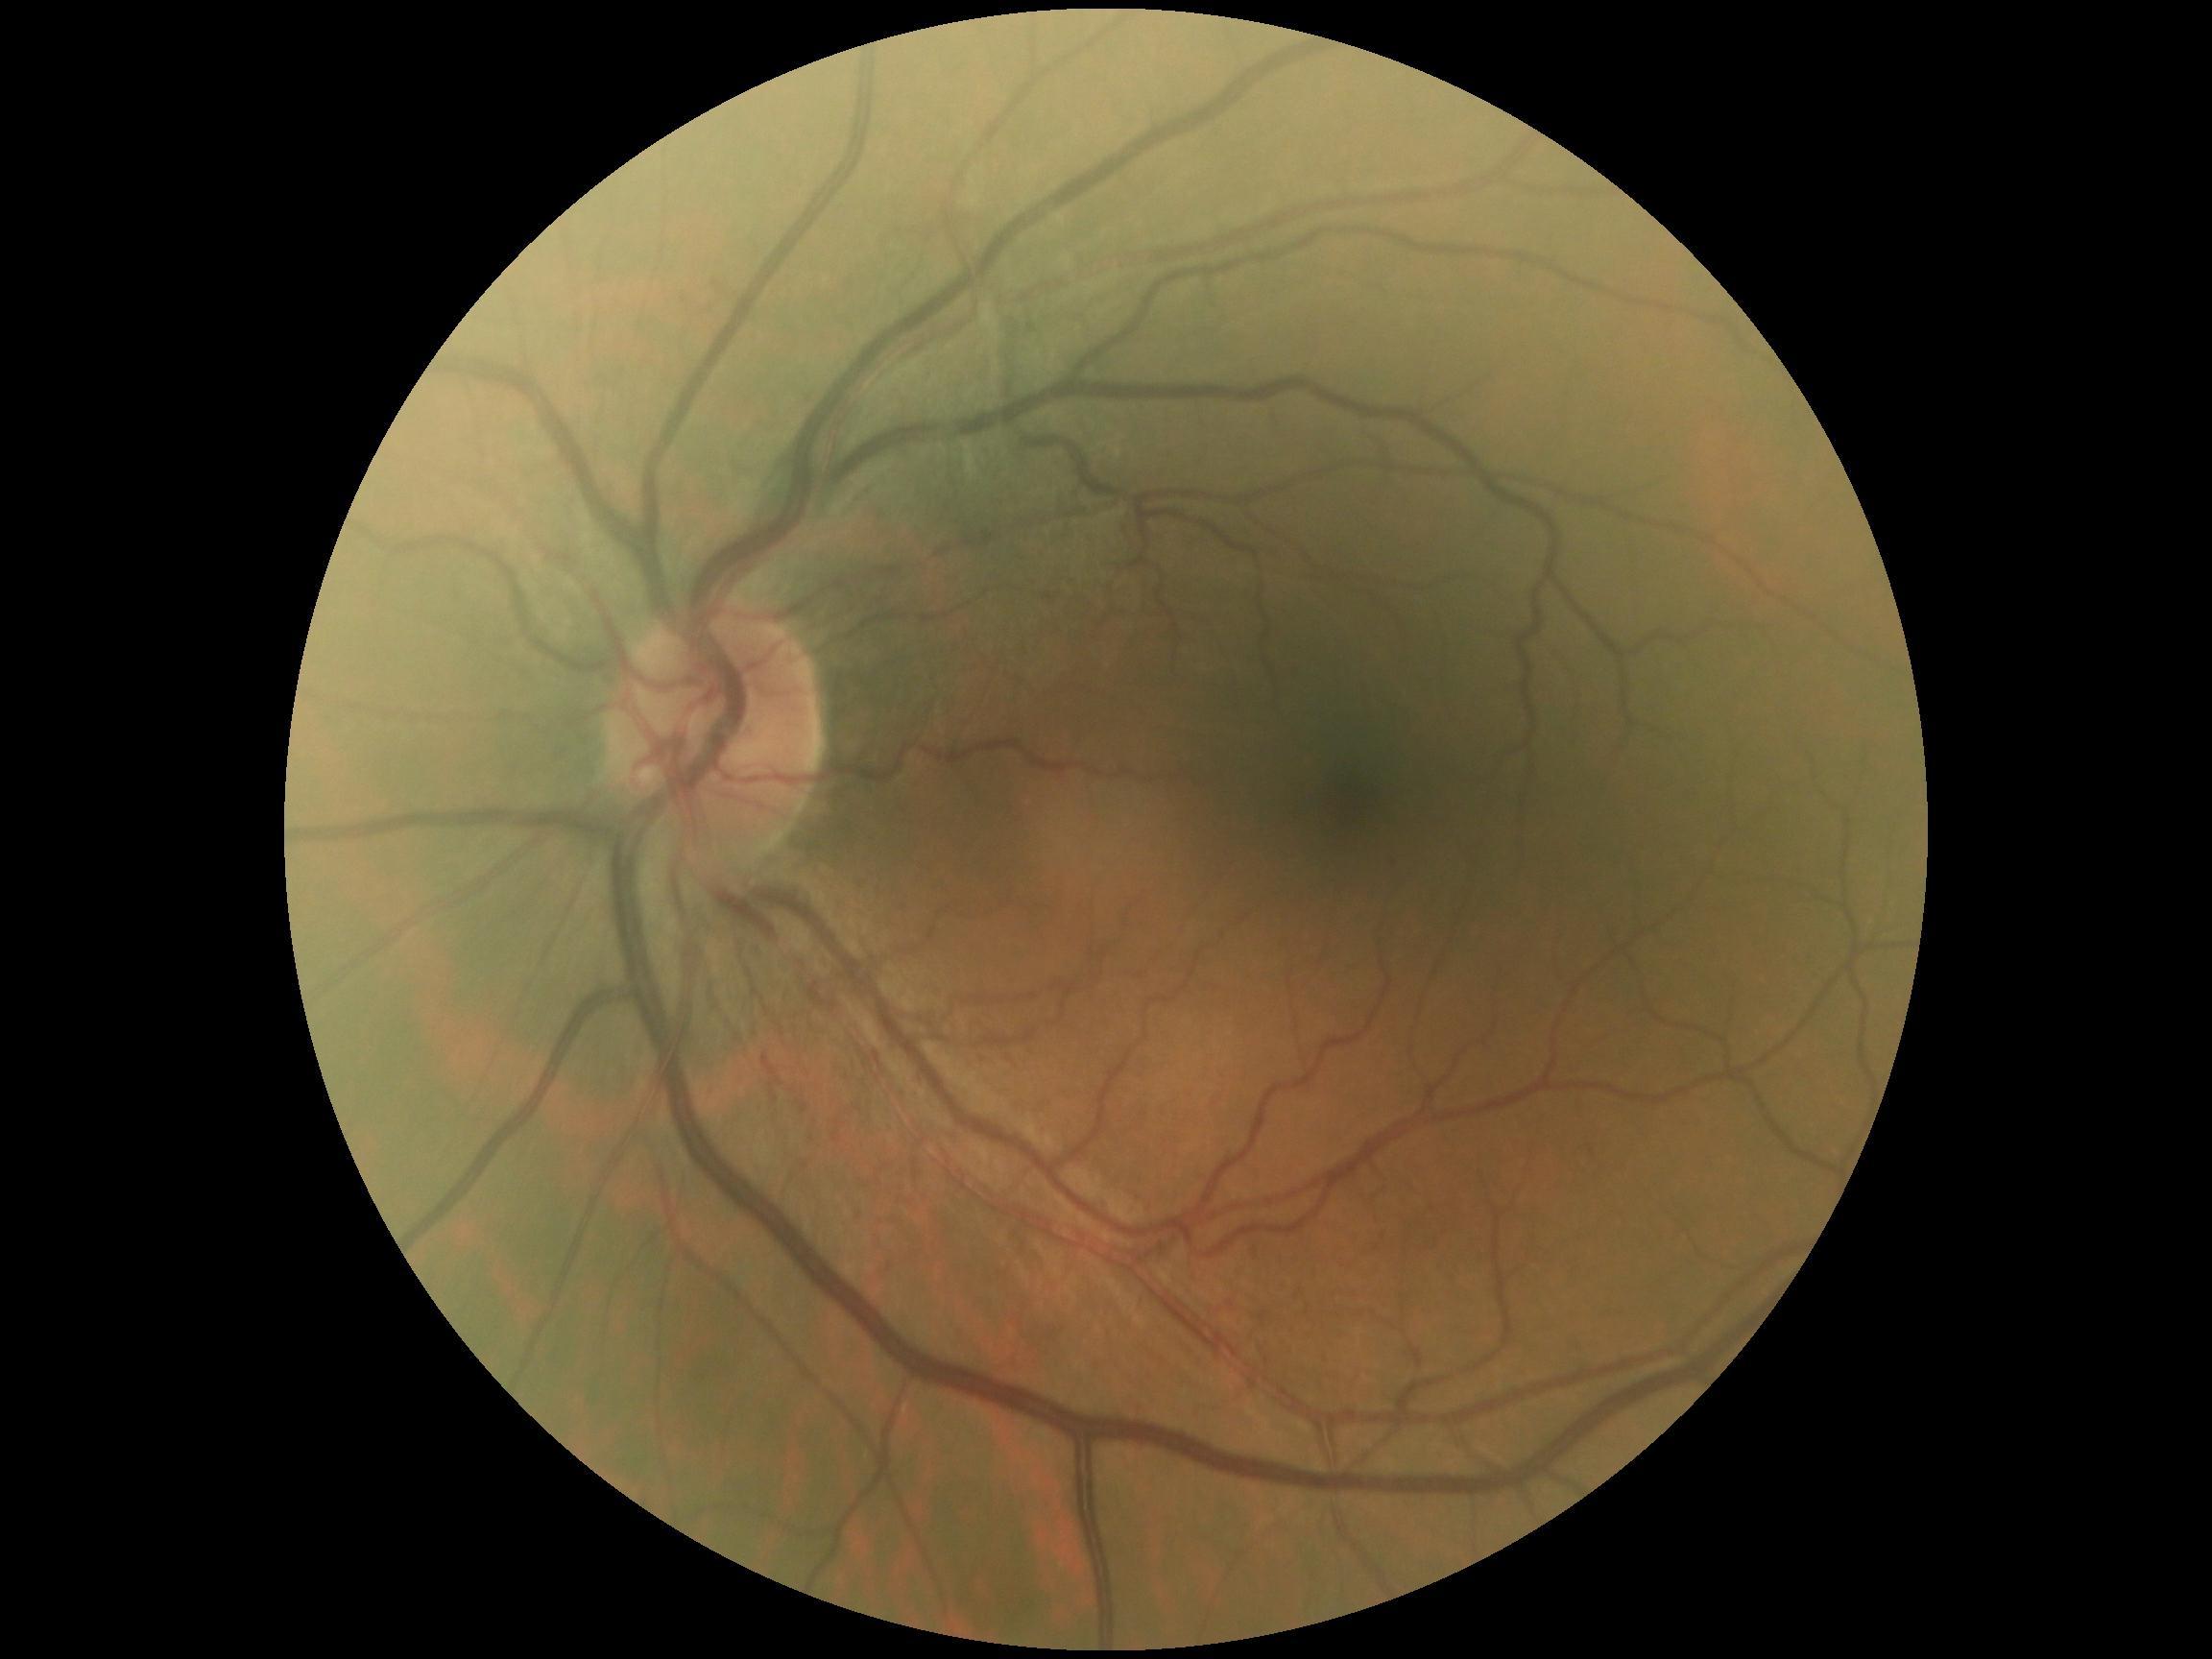

{"dr_grade": "0", "dr_impression": "negative for DR"}